Color fundus photograph — 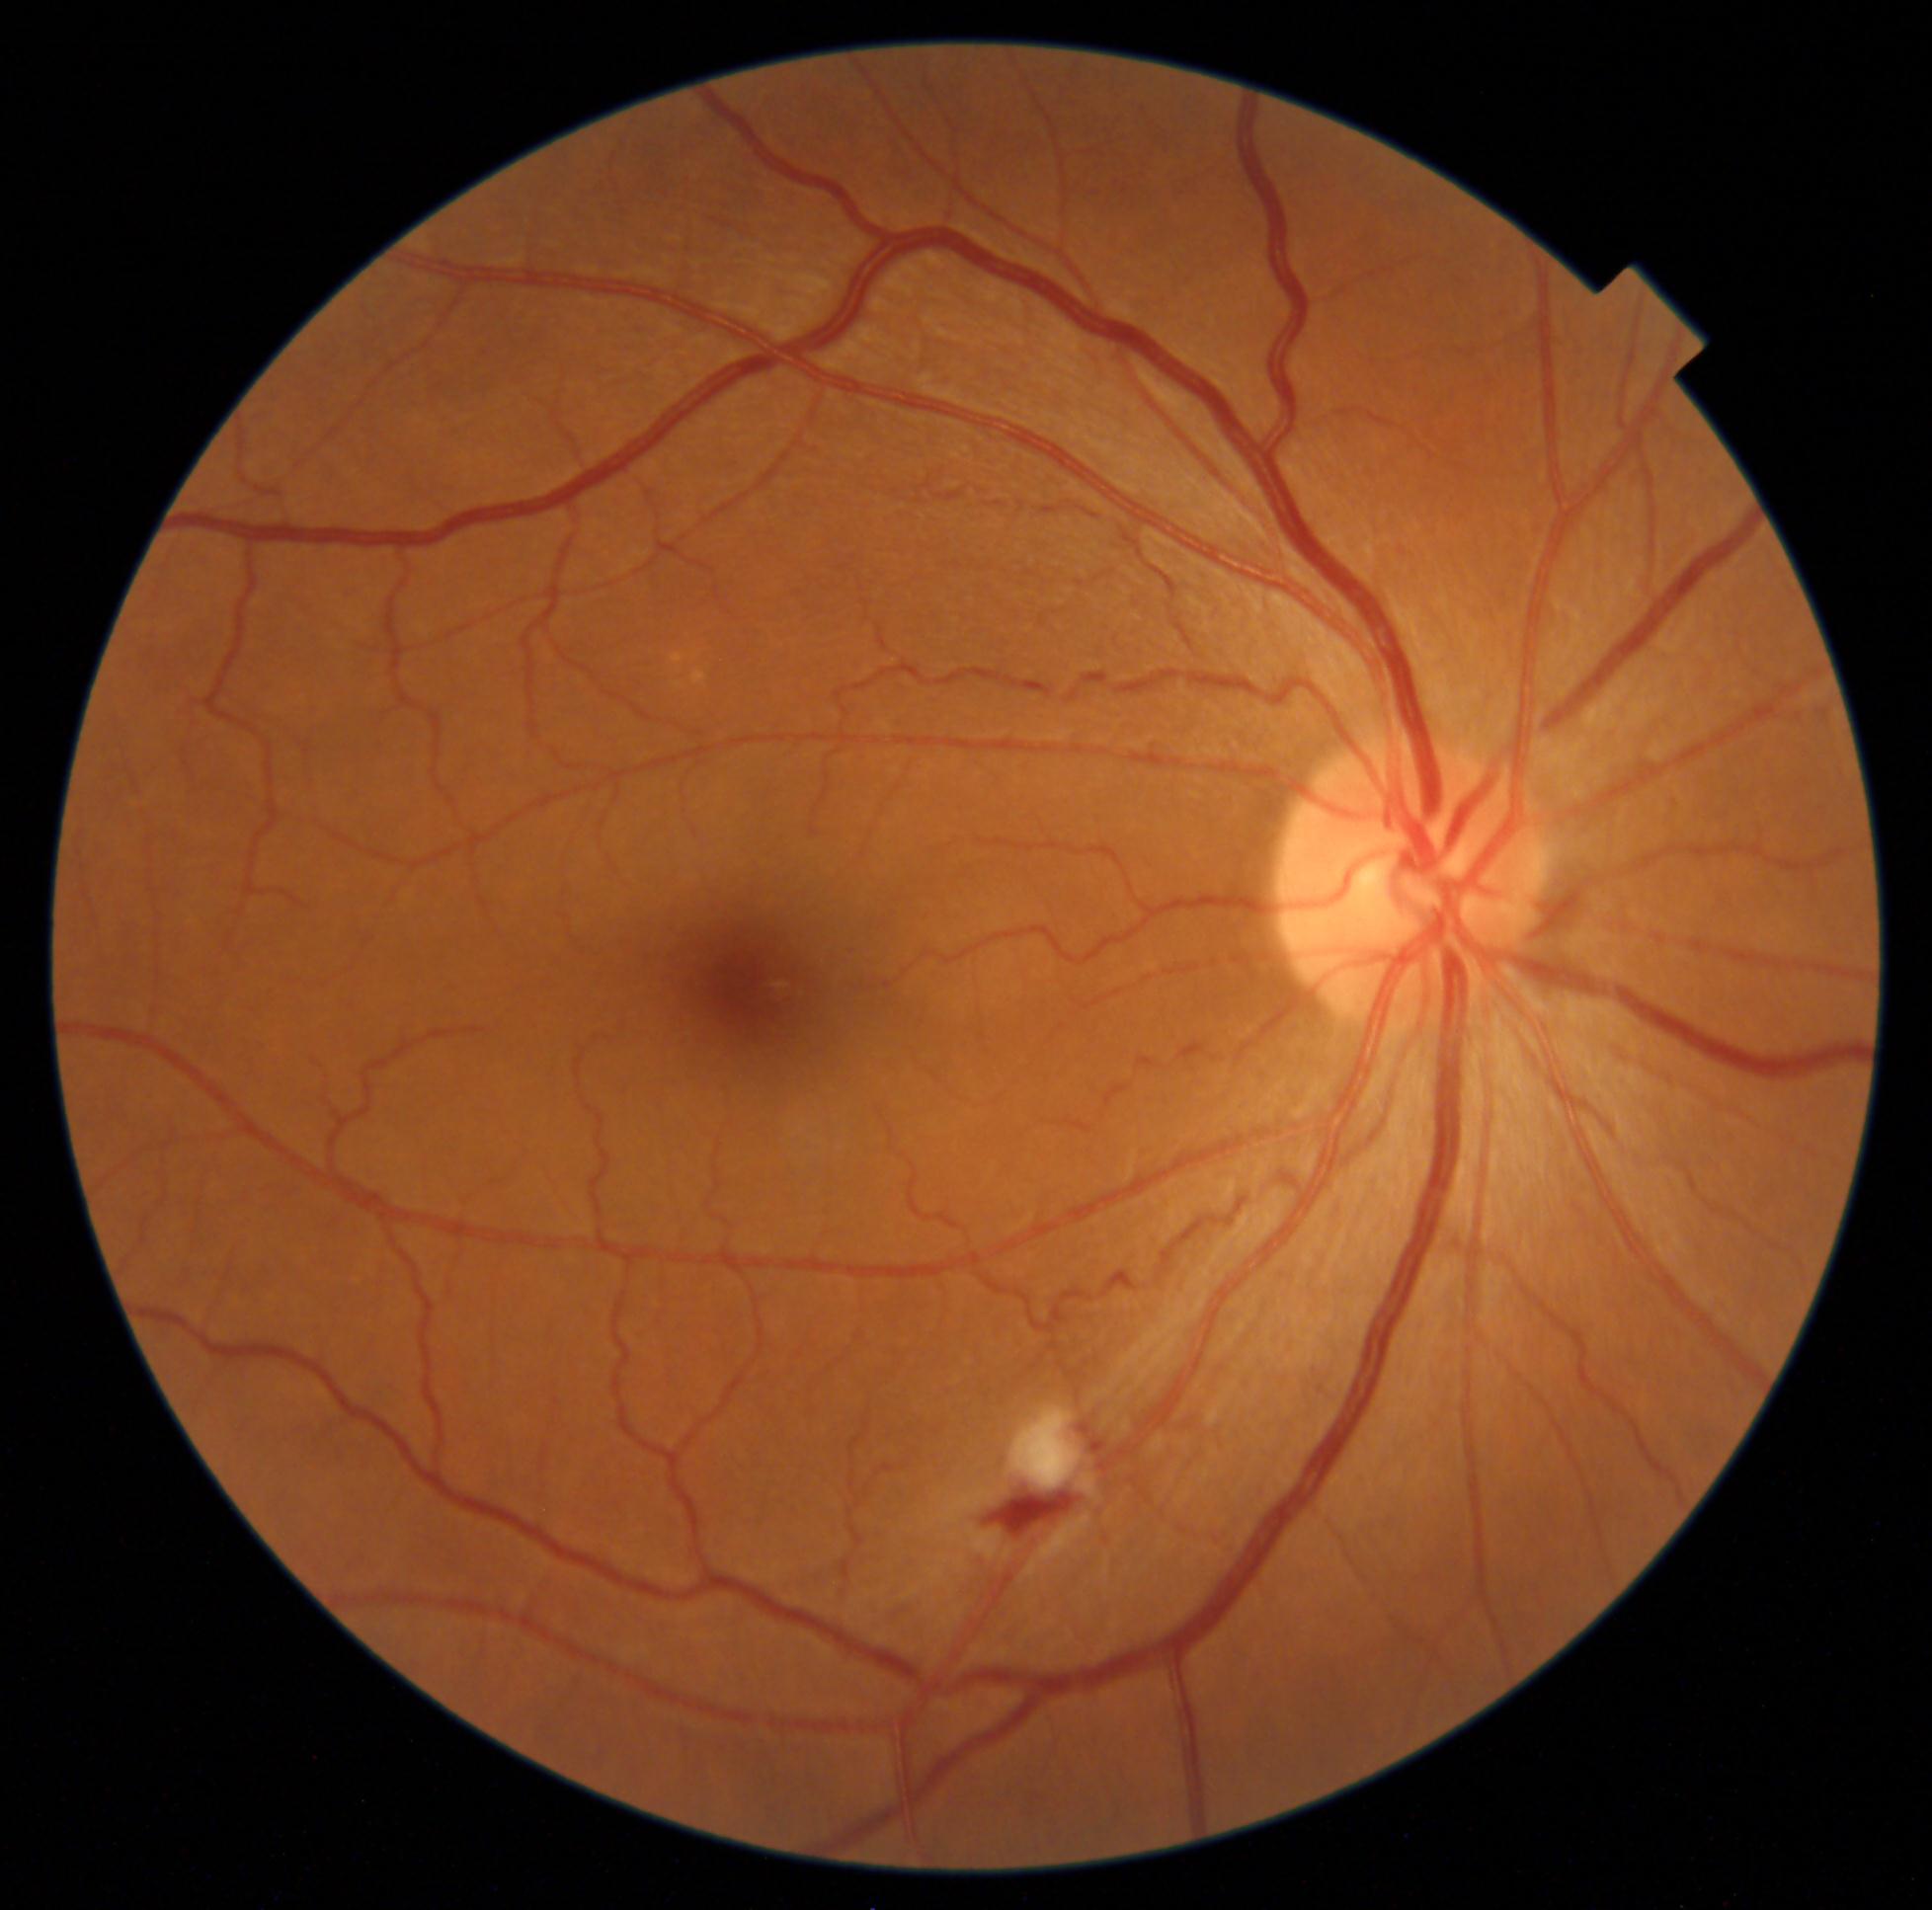 DR stage: grade 2 (moderate NPDR)
EXs: none identified
HEs: 984, 1490, 1085, 1540
MAs: none identified
SEs: 1012, 1406, 1083, 1490